1240 x 1240 pixels. Infant wide-field retinal image
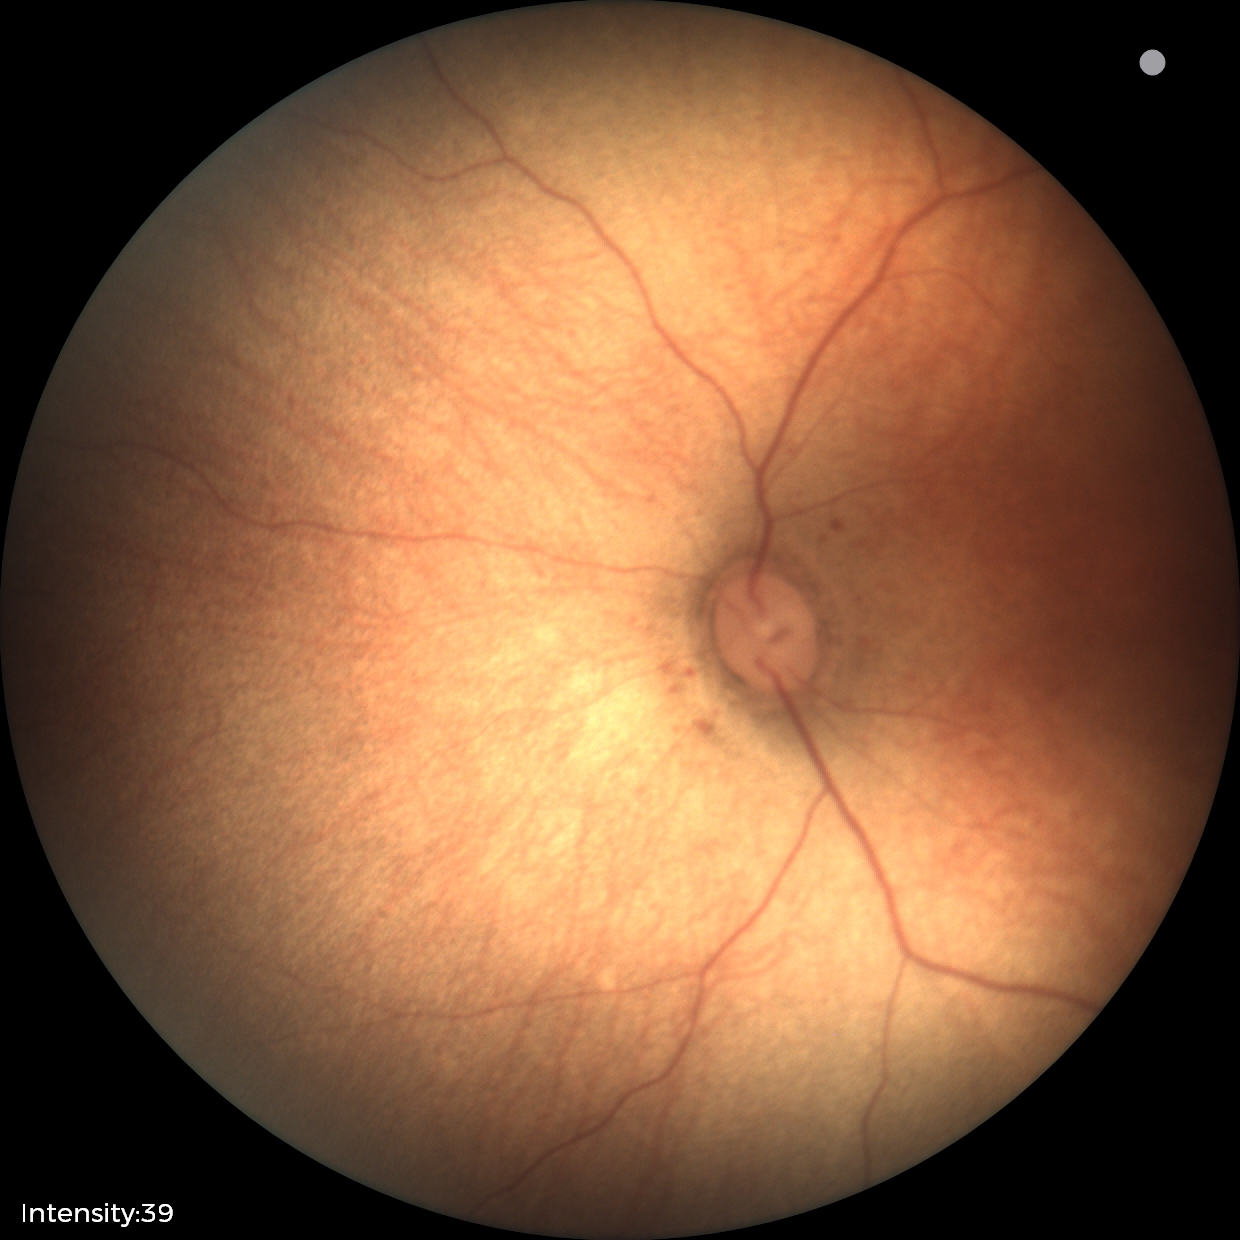
Screening examination with no abnormal retinal findings.